Color fundus image; posterior pole field covering the optic disc and macula — 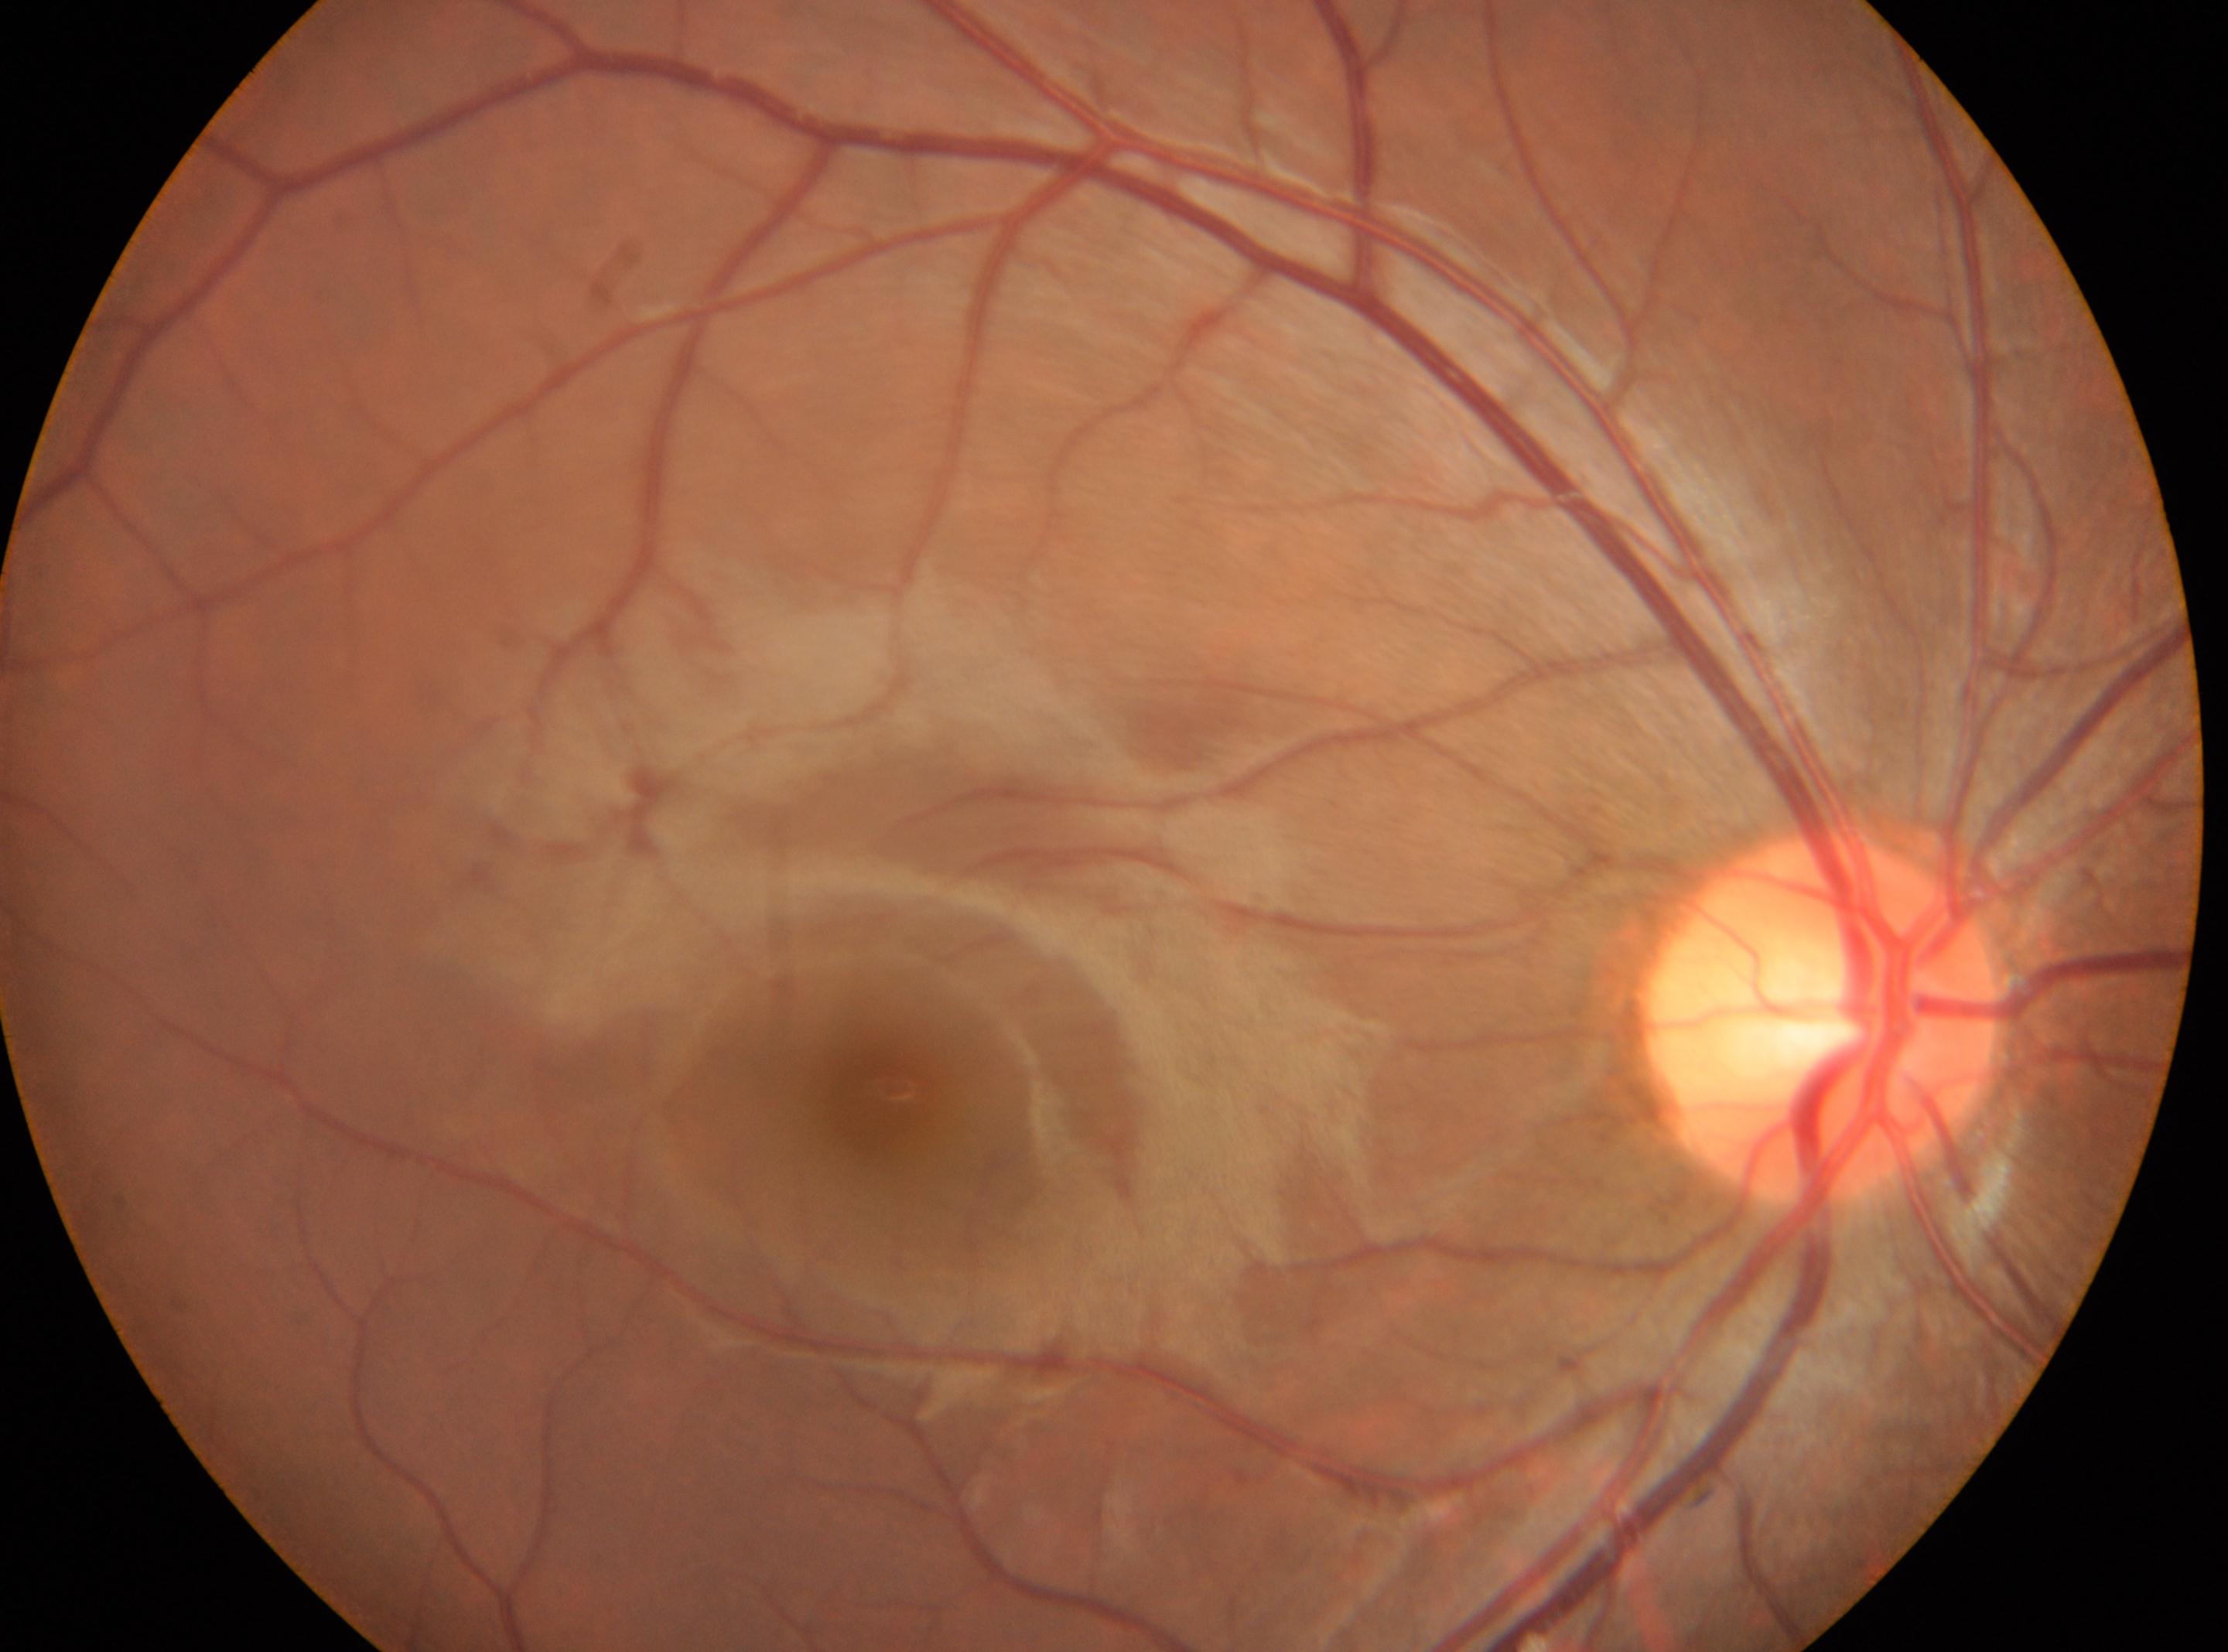
the optic disc@1823, 1019; DR grade@0; oculus dexter; fovea center@890, 1089.